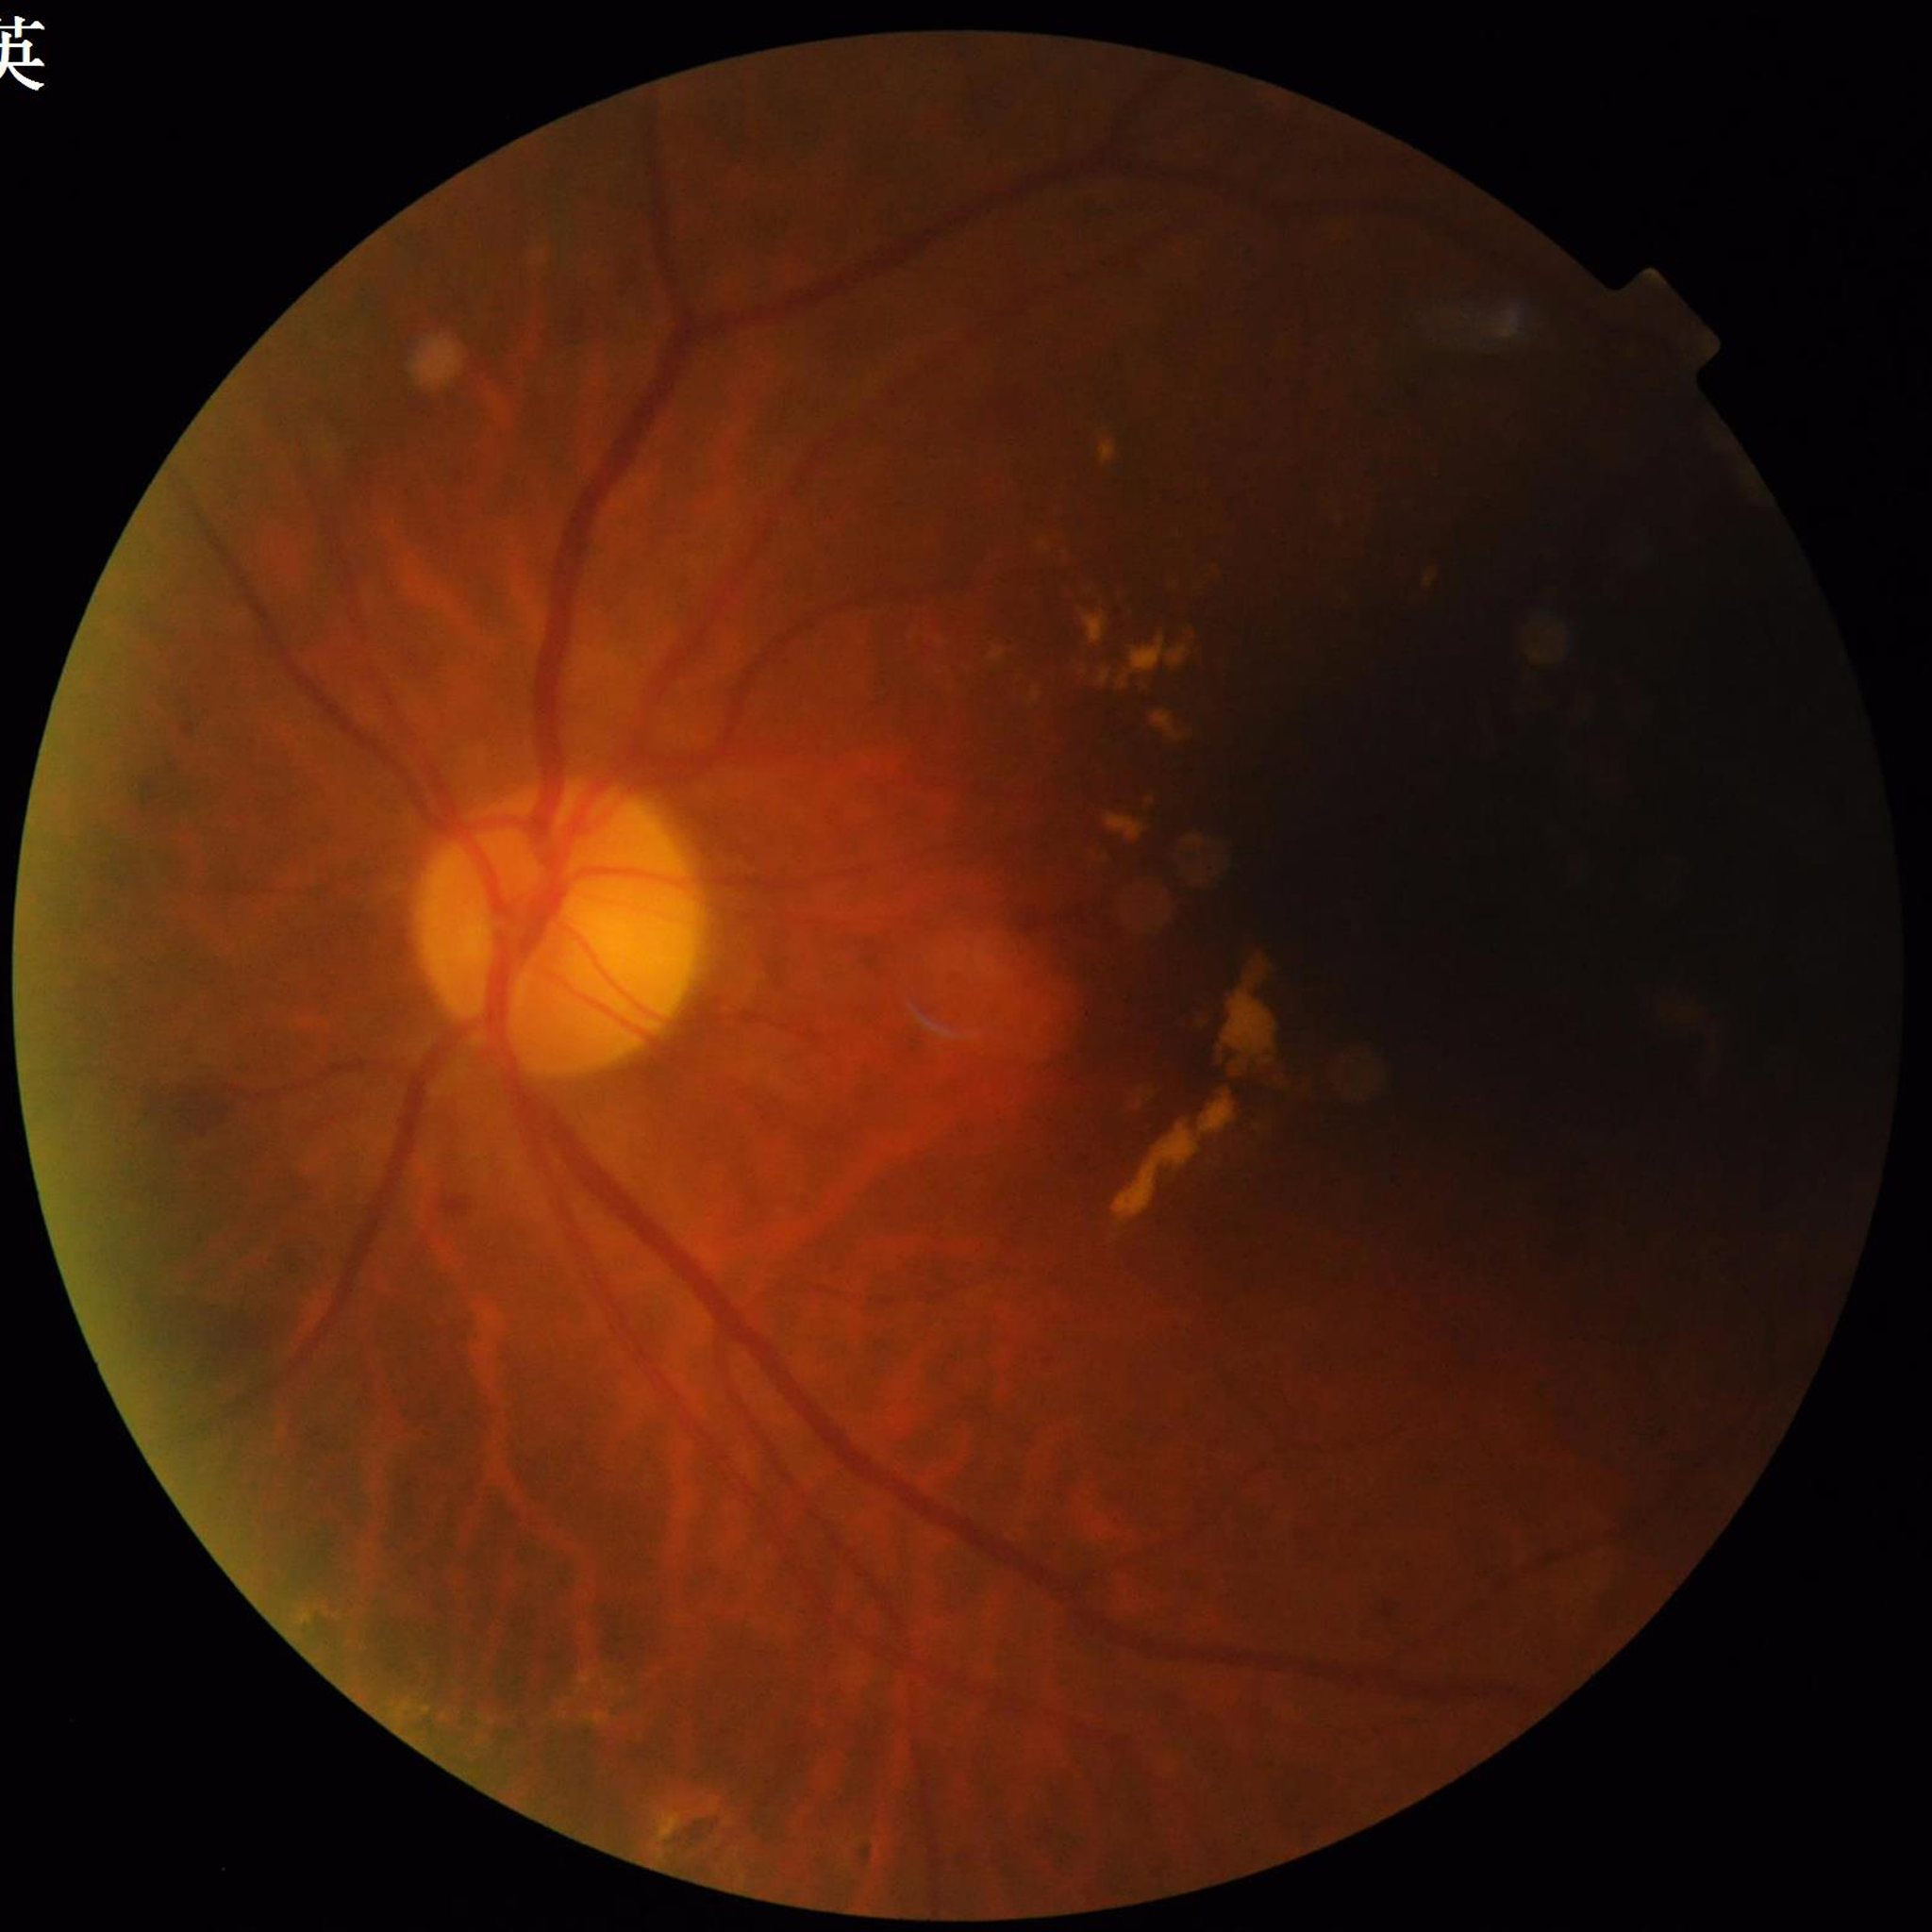

Diagnosed with DR. Quality assessment: issues noted — illumination/color distortion, blur.